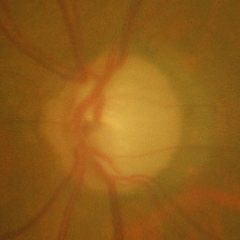

Fundus image with findings of severe glaucomatous damage.